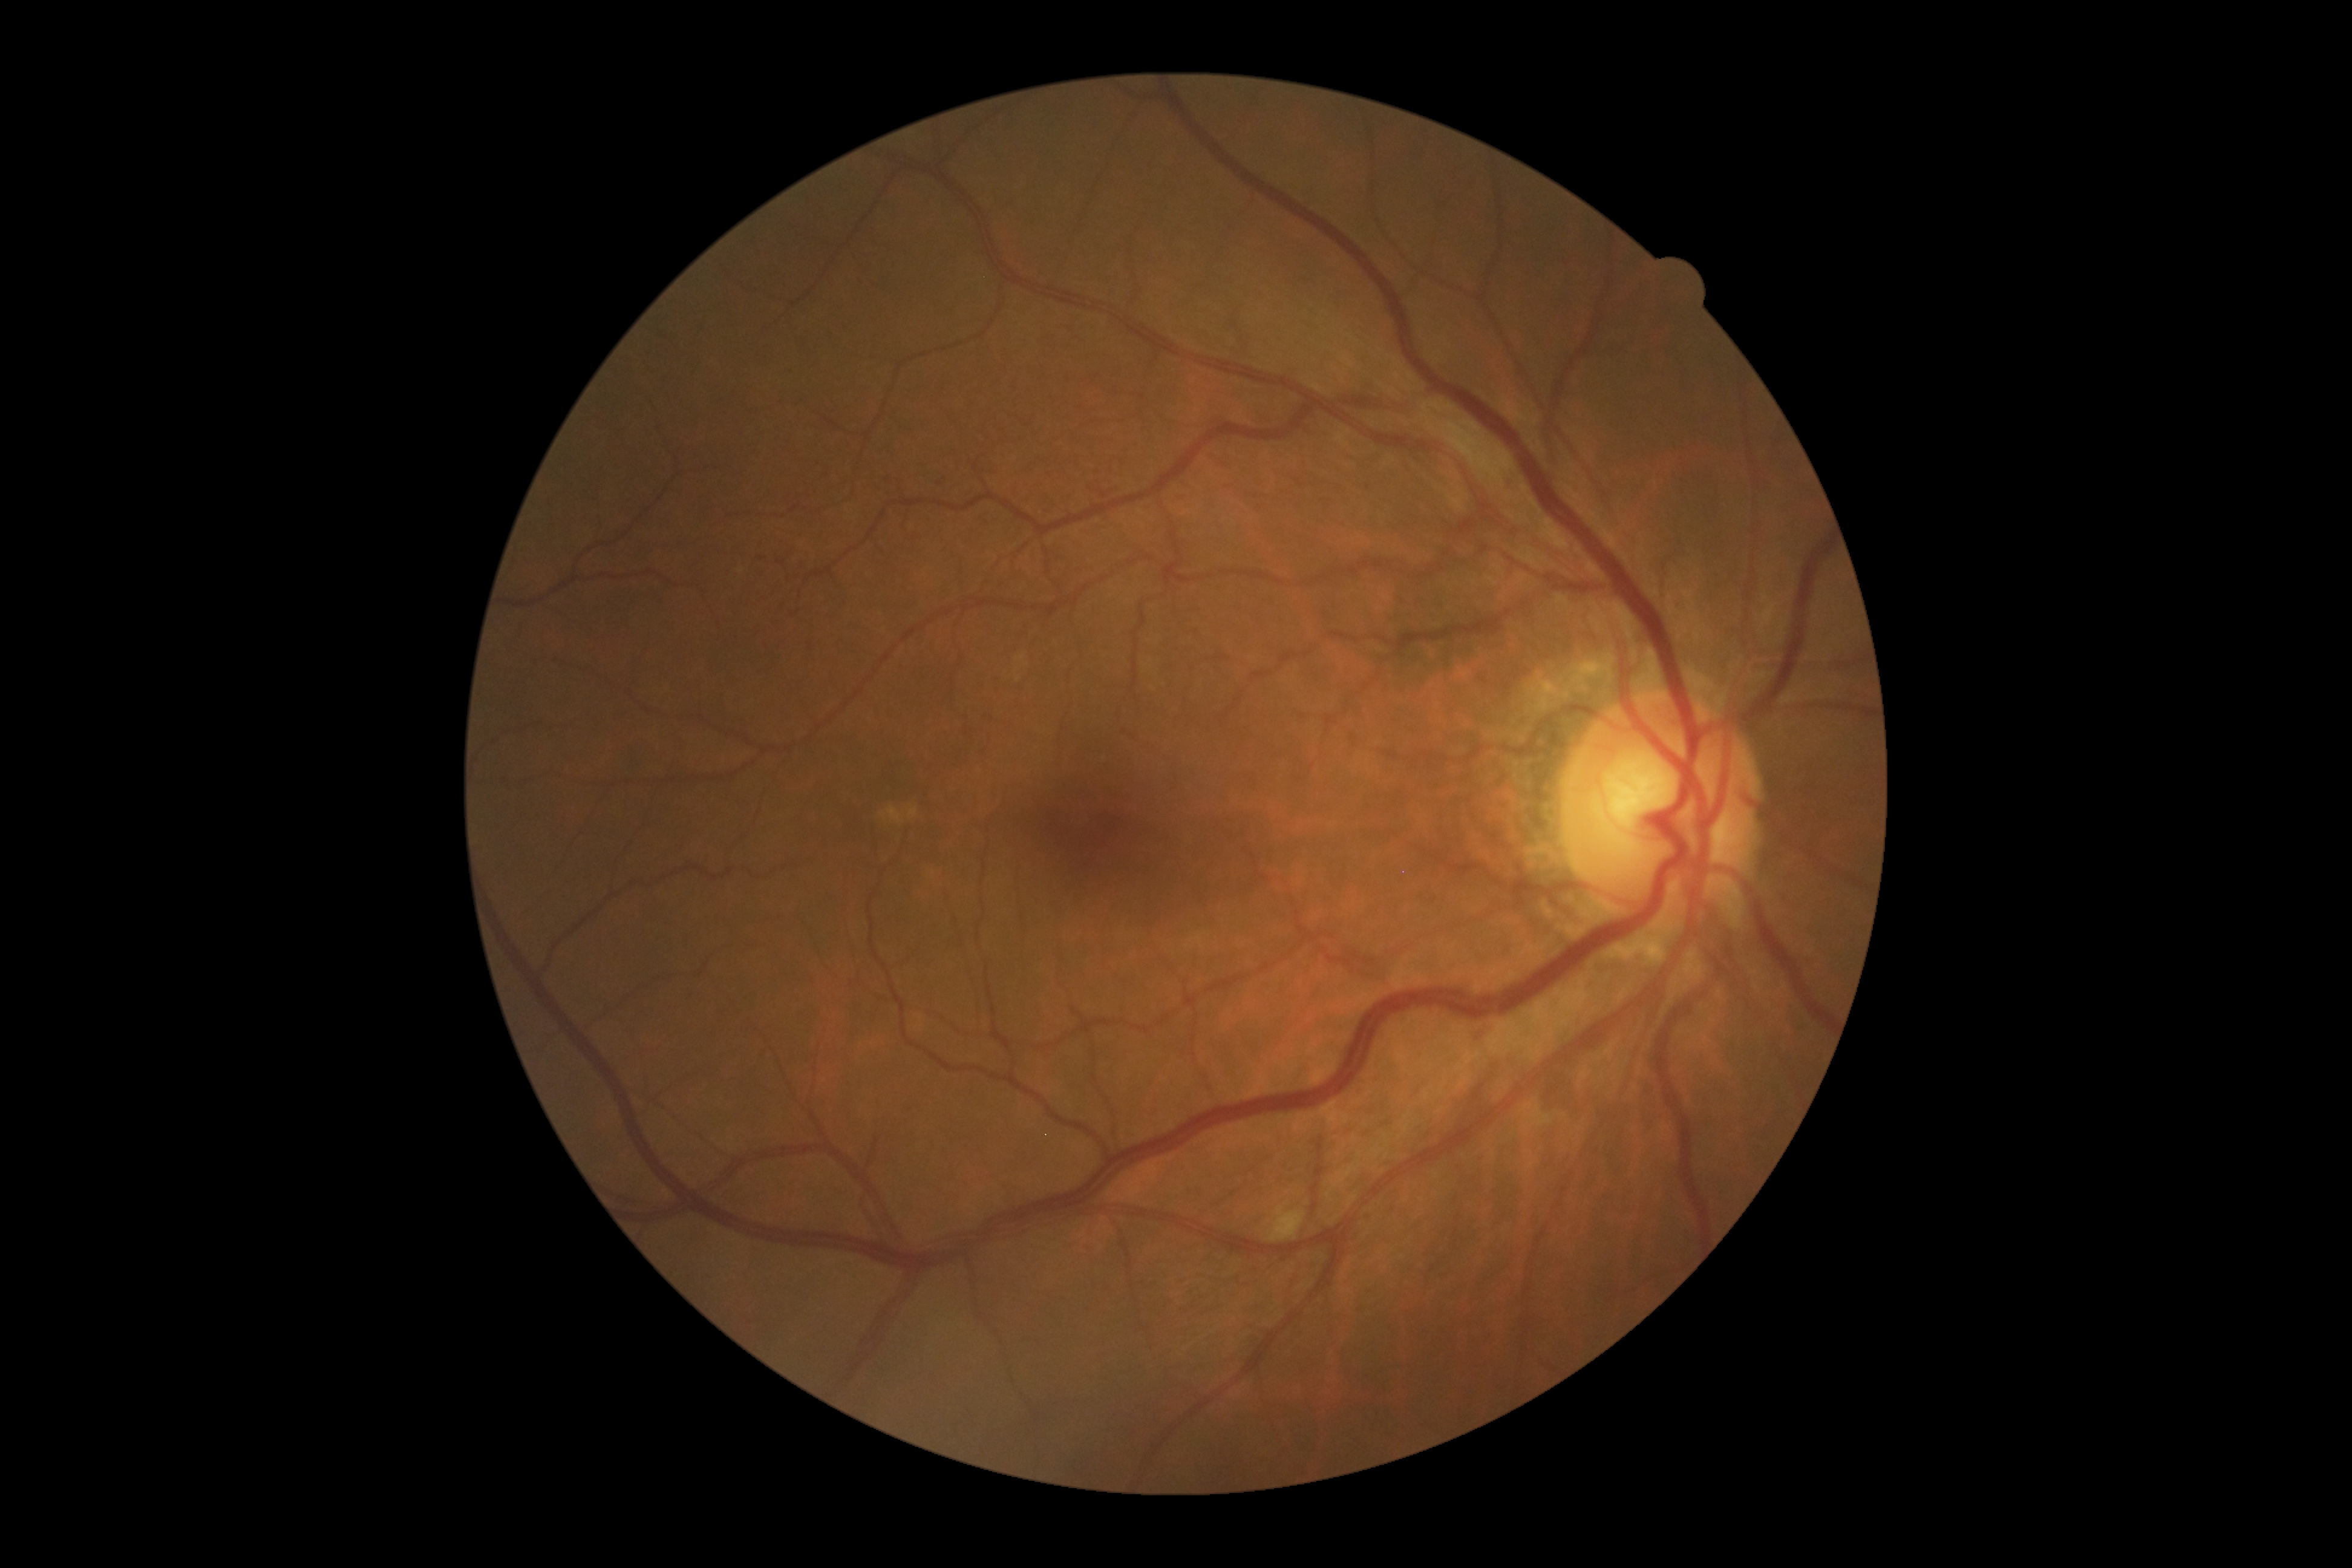 {
  "dr_grade": "2",
  "dr_category": "non-proliferative diabetic retinopathy"
}